FOV: 45 degrees: 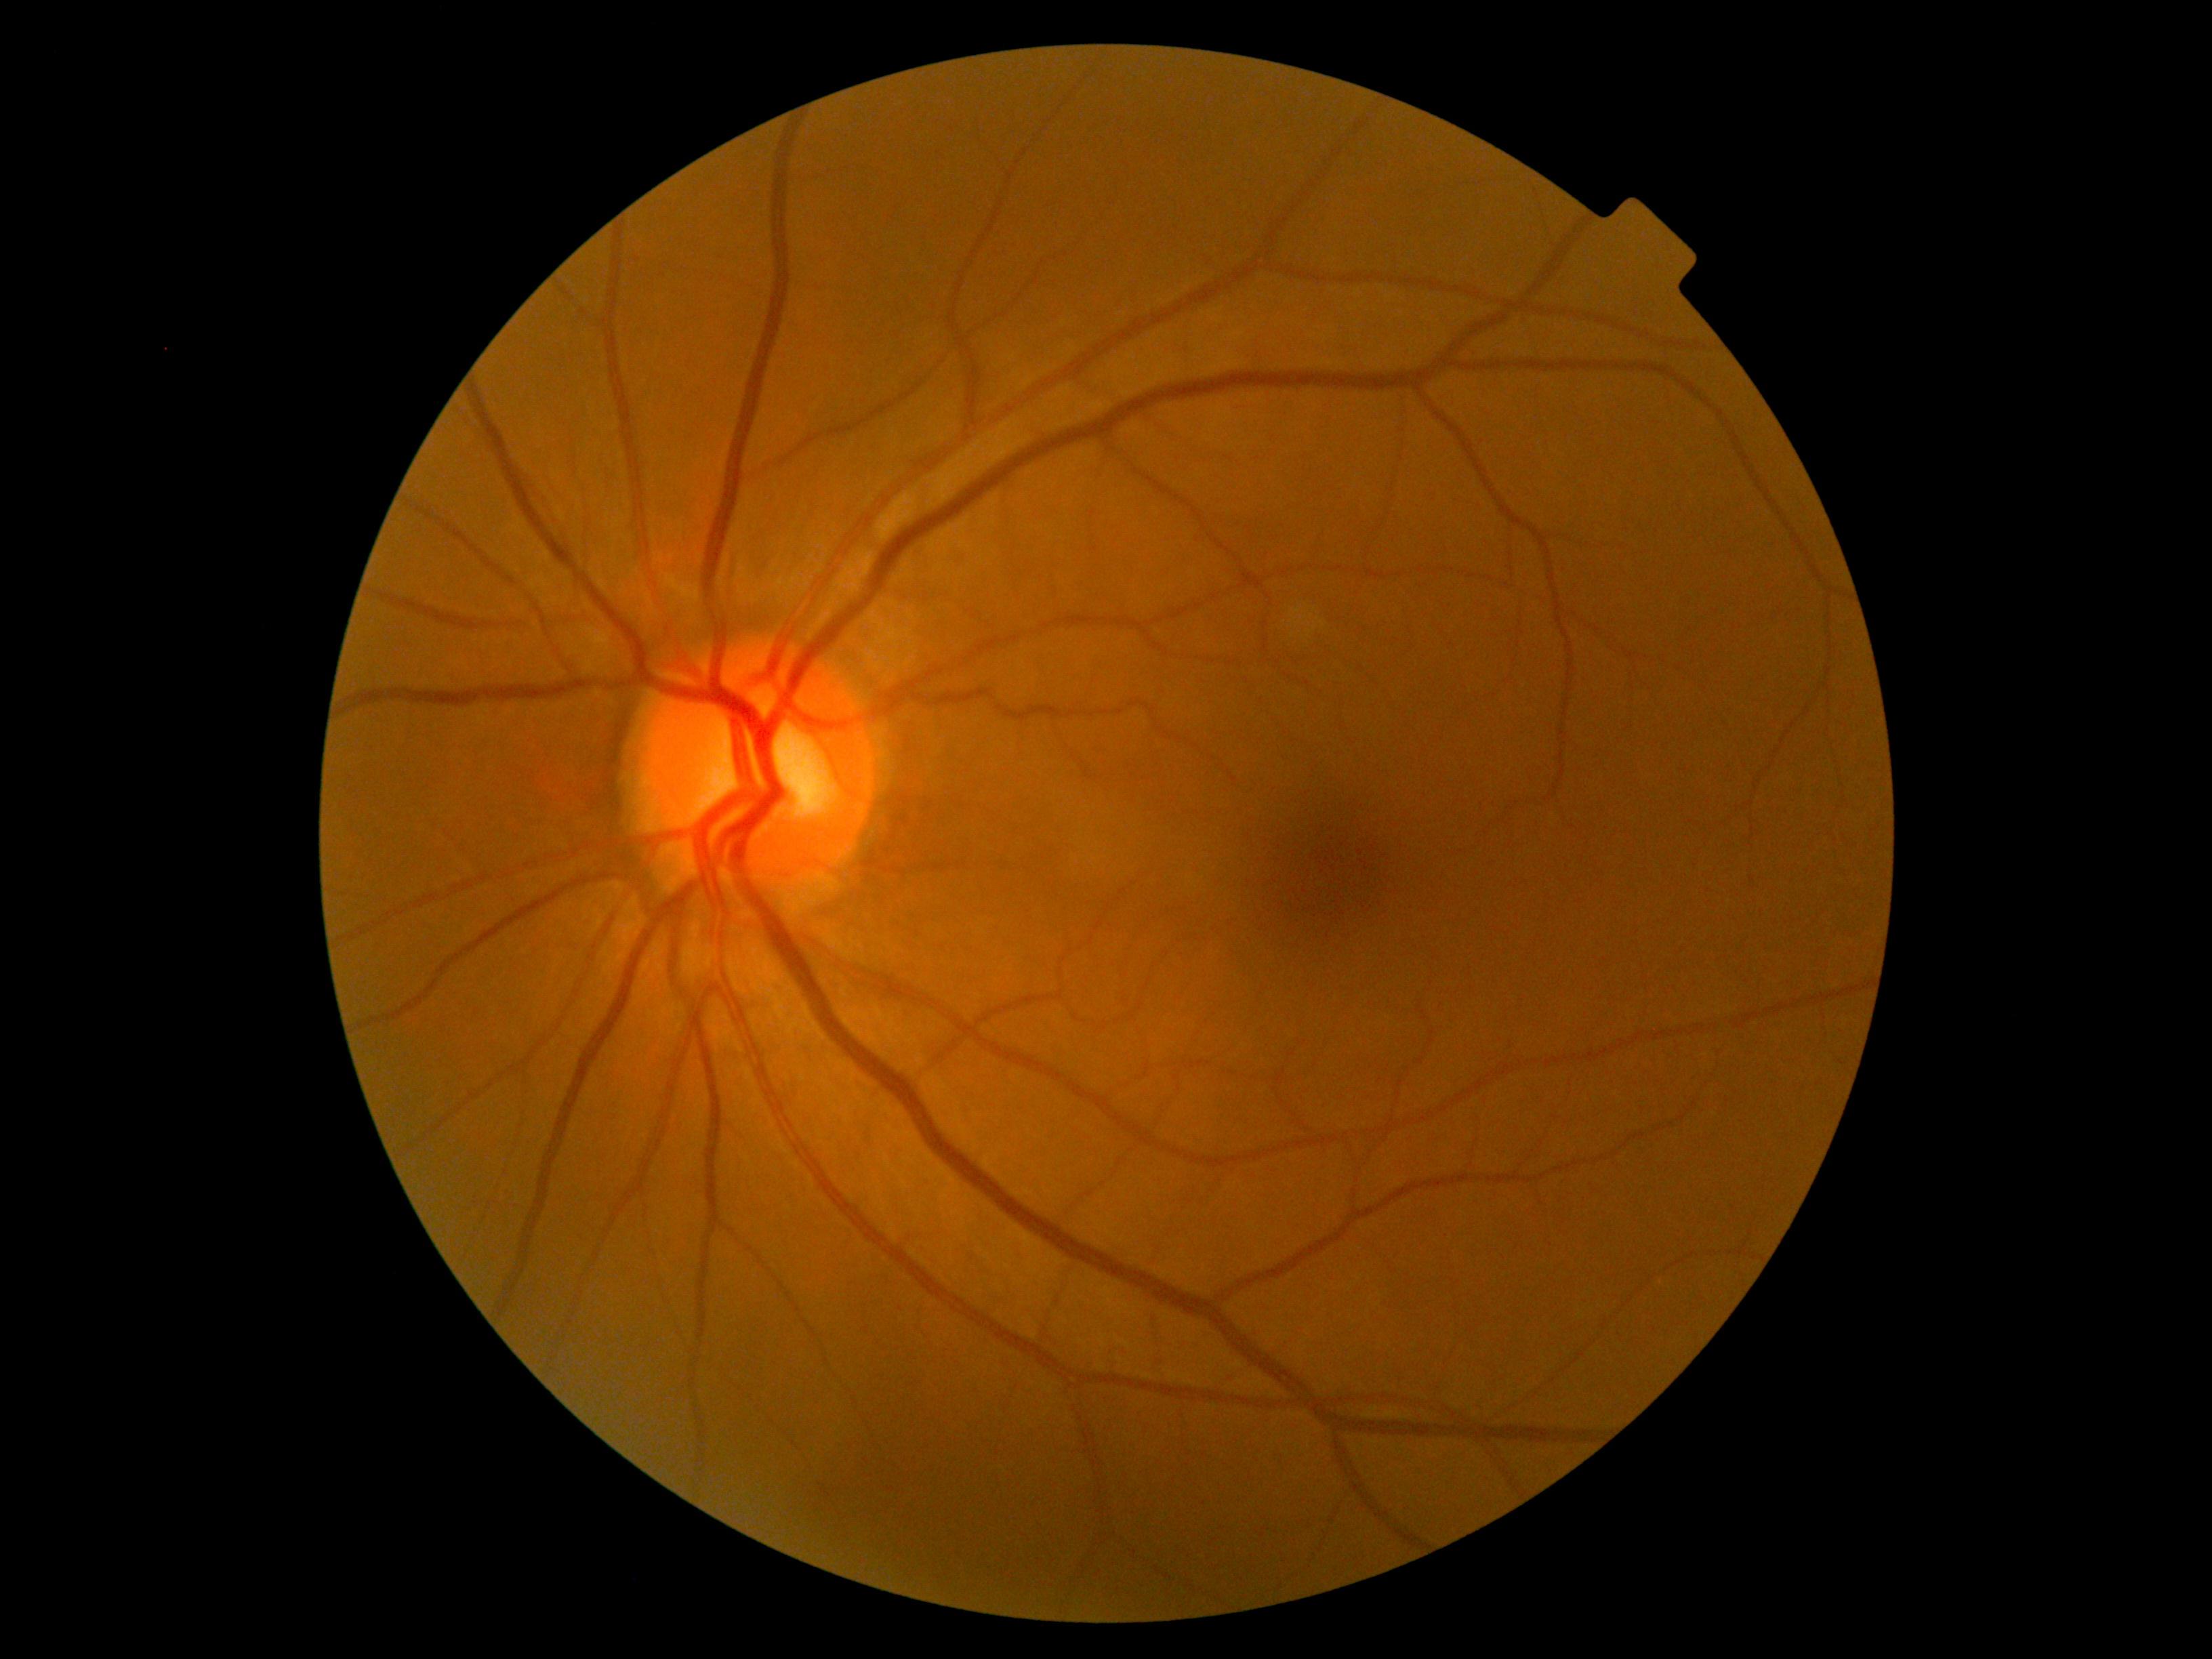 DR severity: grade 0 (no apparent retinopathy).